Mydriatic (tropicamide phenylephrine 1.0%) — 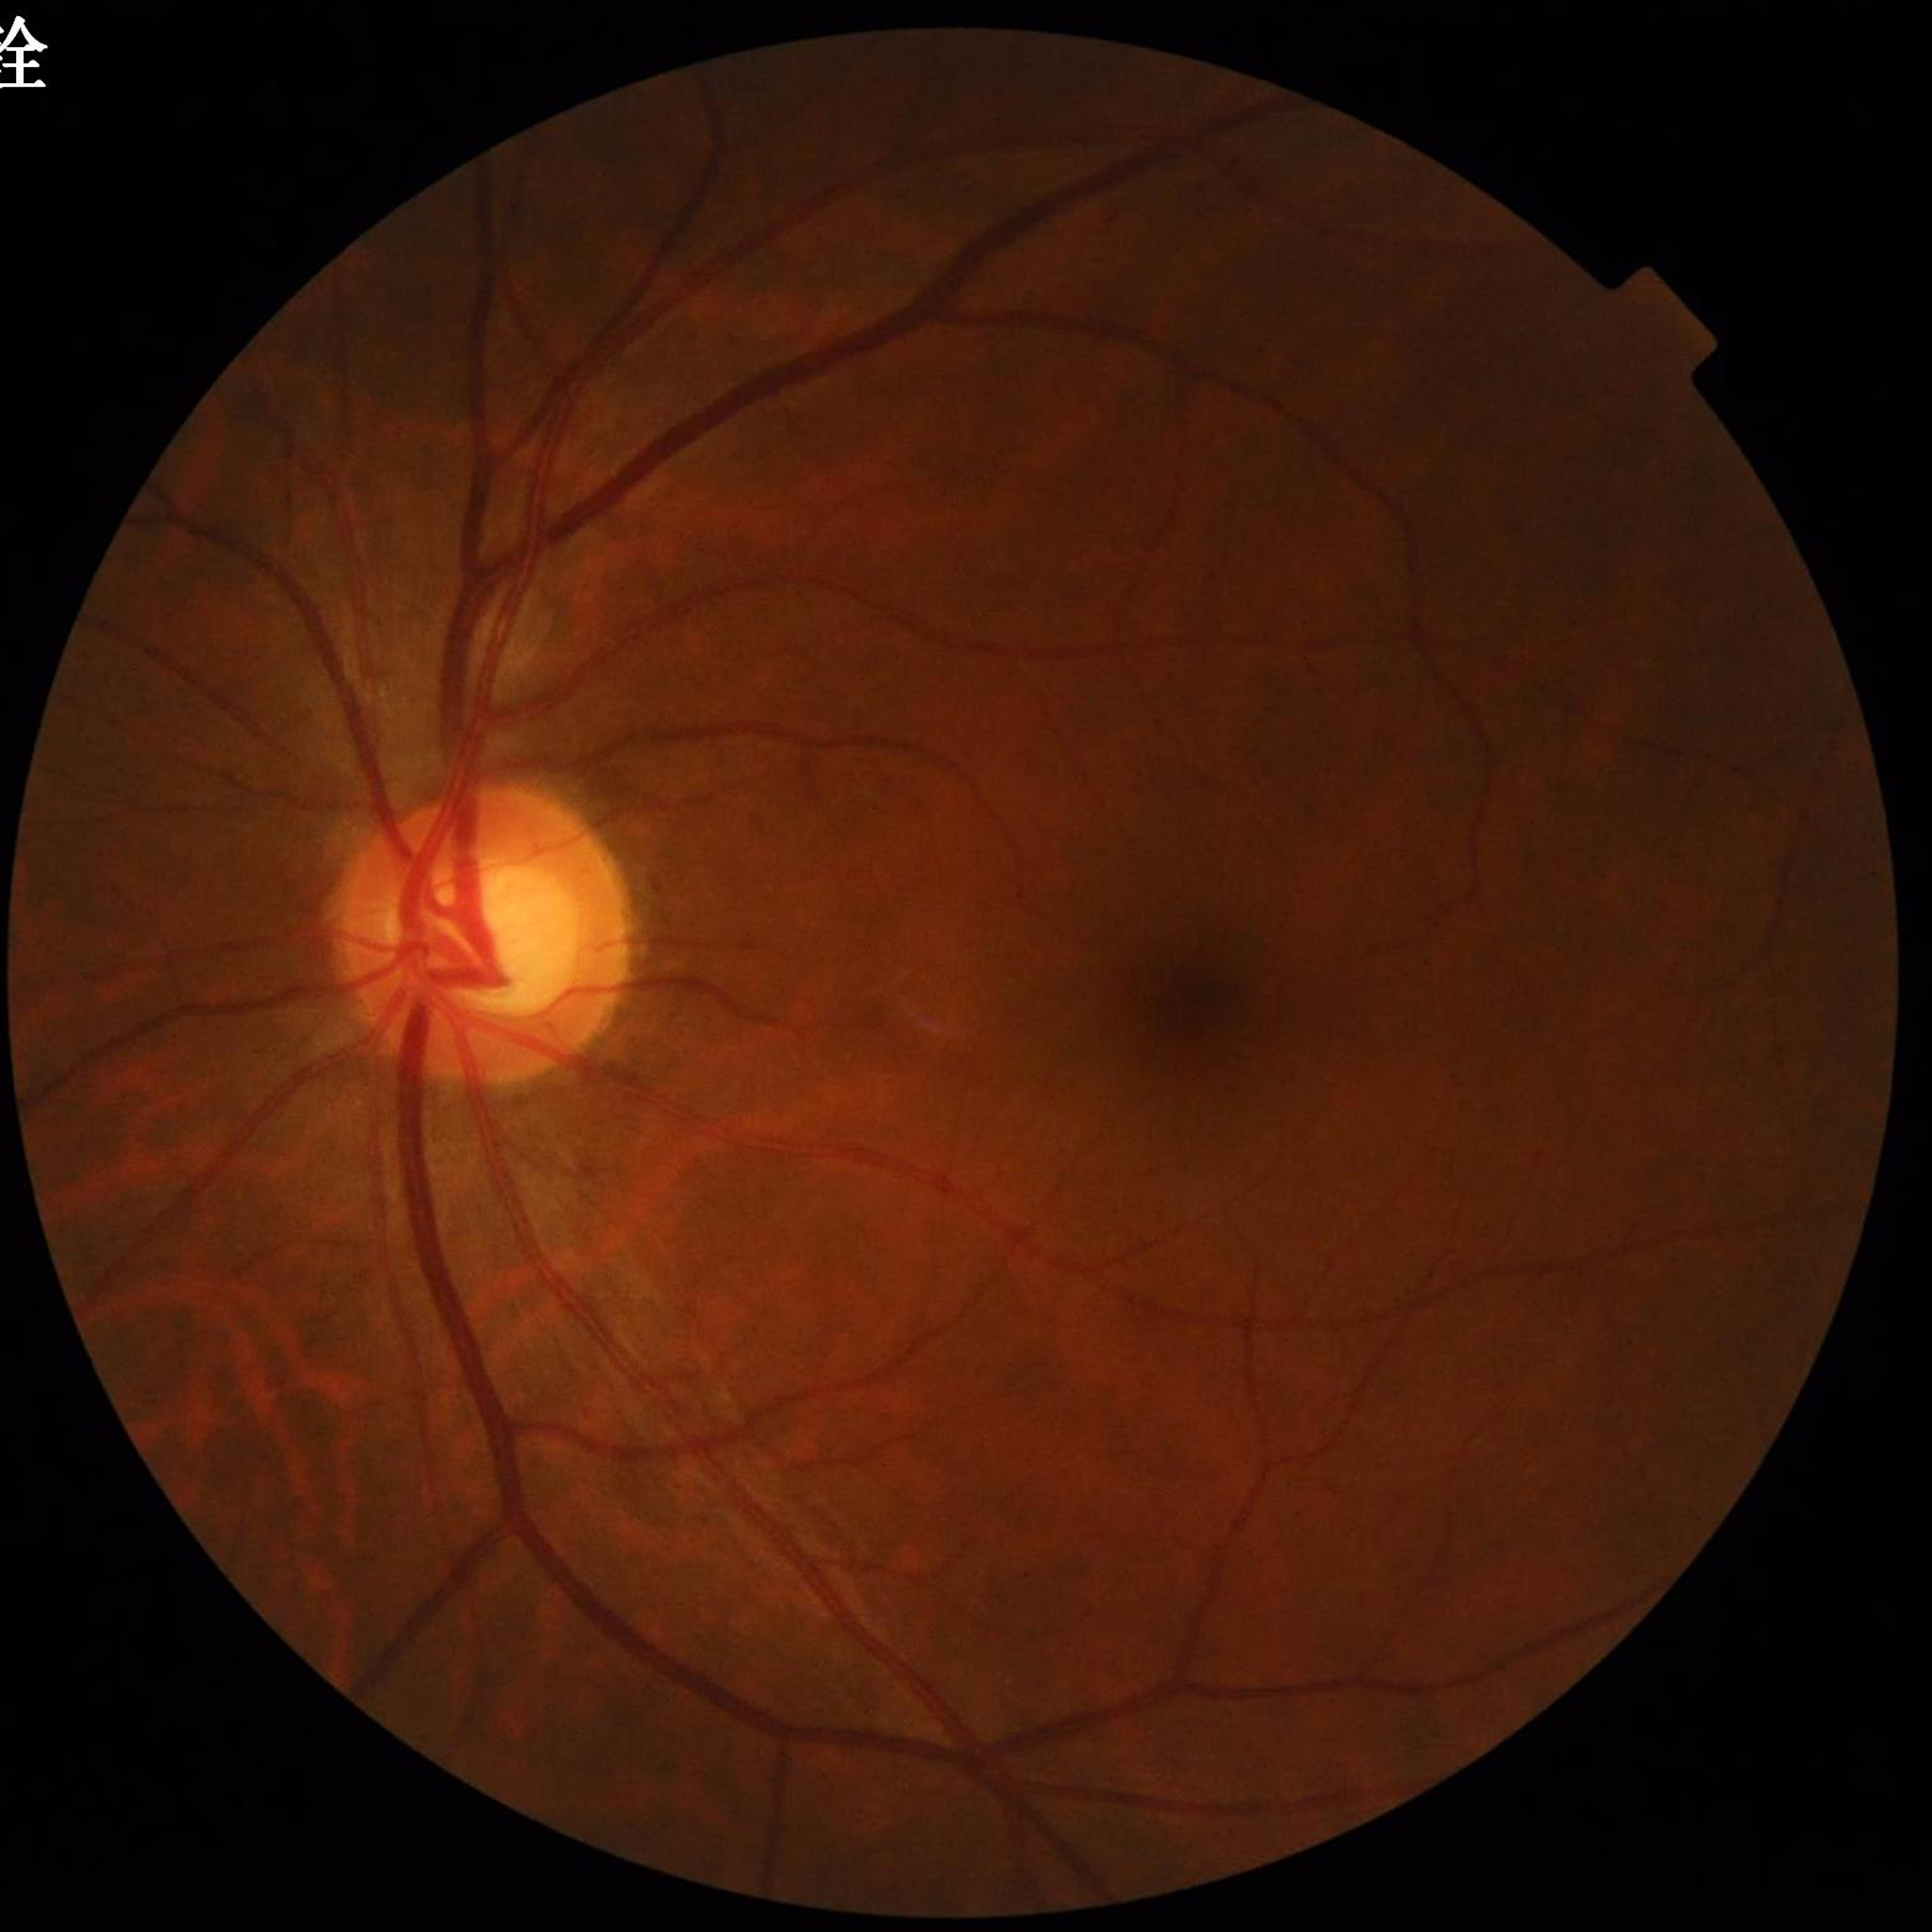

diagnosis: glaucoma